Retinal fundus photograph; 45-degree field of view.
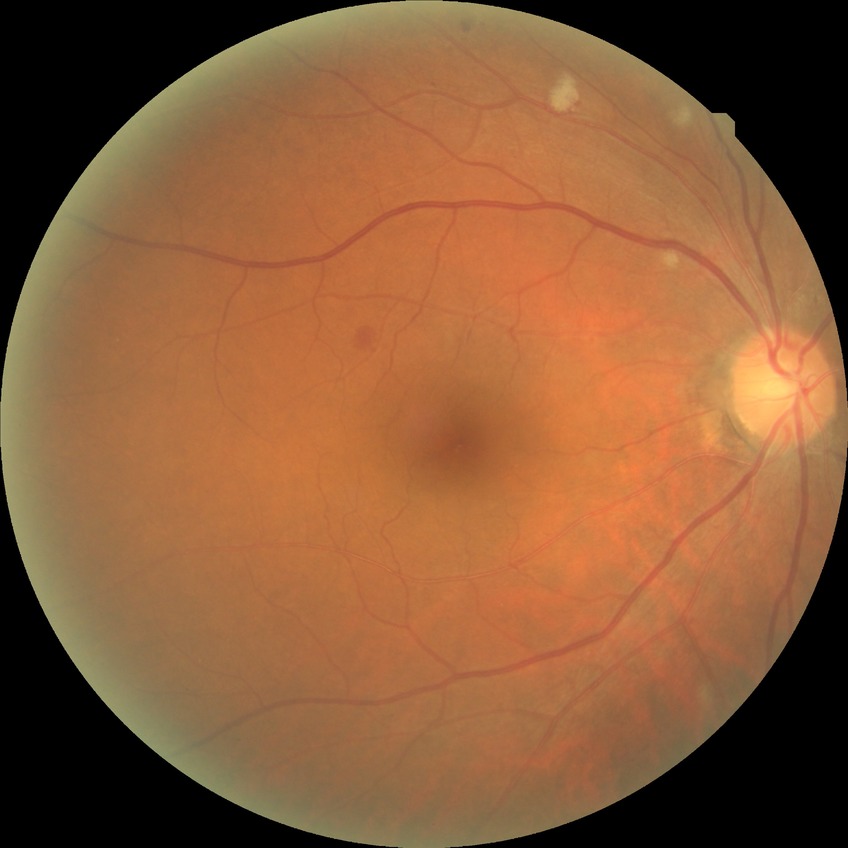

davis_grade: simple diabetic retinopathy